Camera: Nidek AFC-330
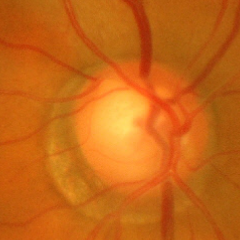

Glaucoma assessment = advanced glaucoma.